50° FOV; acquired with a Kowa VX-10α; captured after pupil dilation; macula-centered; color fundus image; 2361 by 1568 pixels: 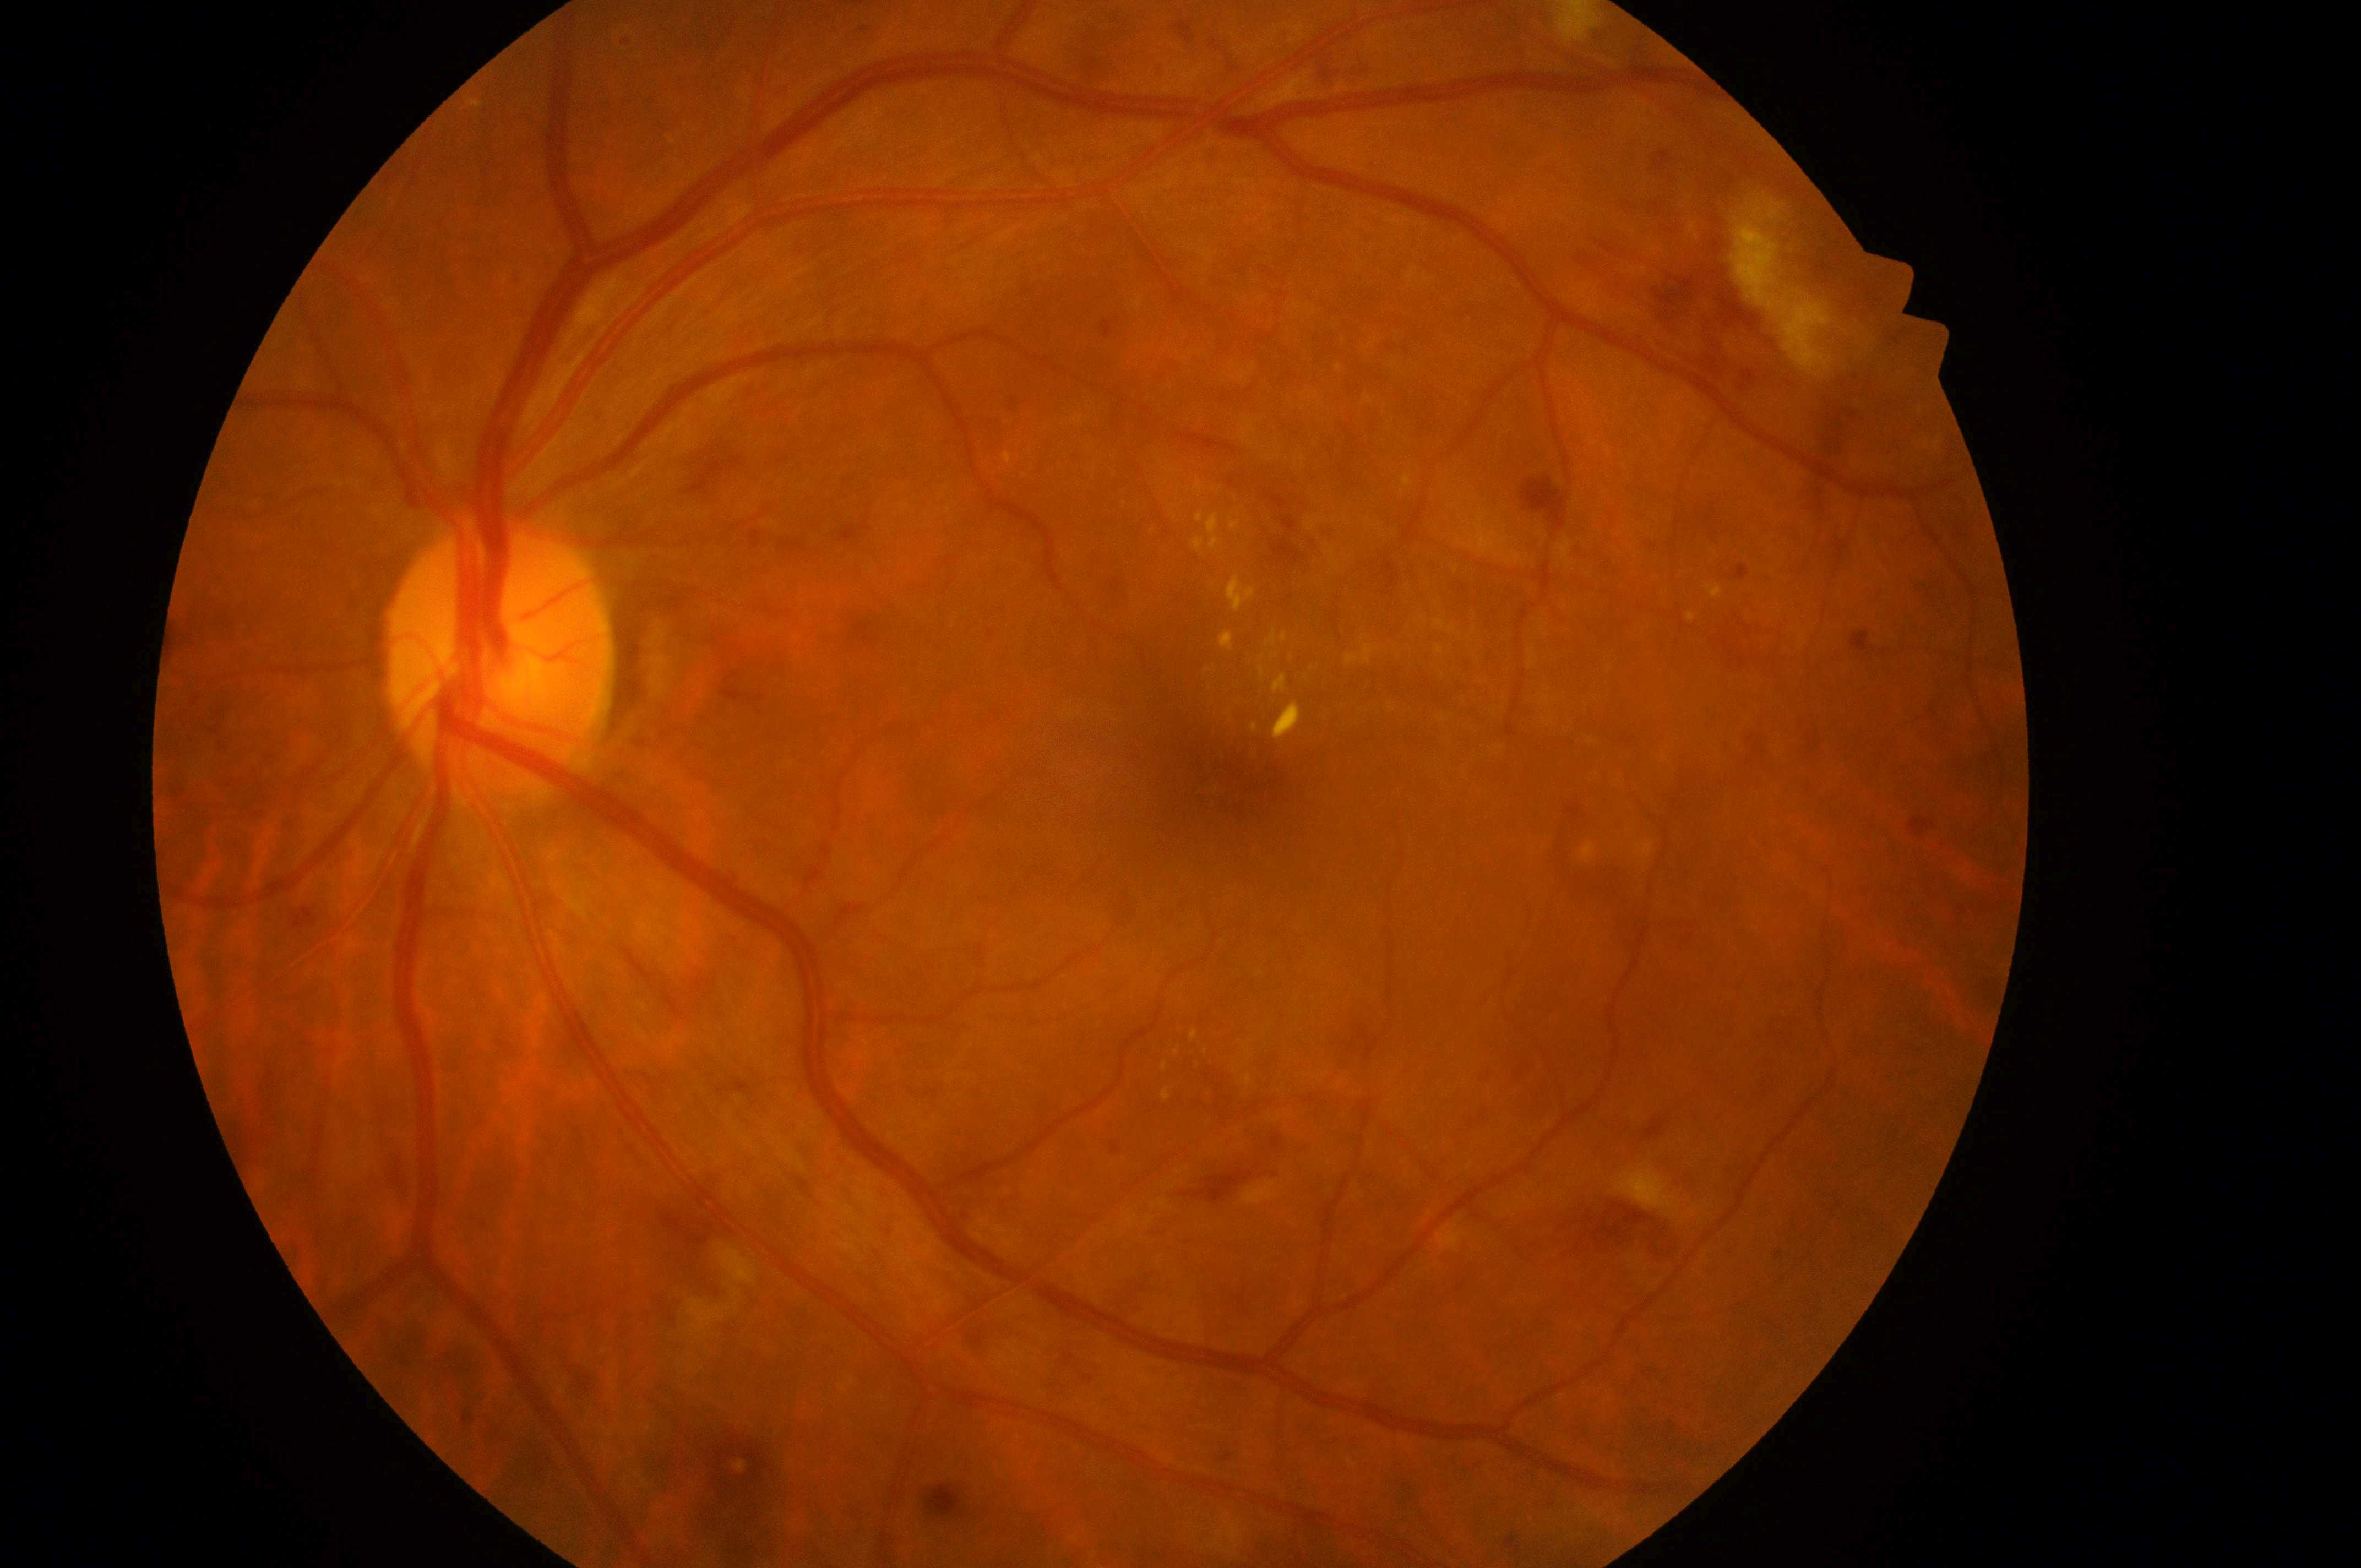
– diabetic macular edema: high risk (grade 2)
– laterality: the left eye
– diabetic retinopathy severity: severe non-proliferative diabetic retinopathy (grade 3)
– optic disc: (491,668)
– fovea center: (1223,790)